45-degree field of view:
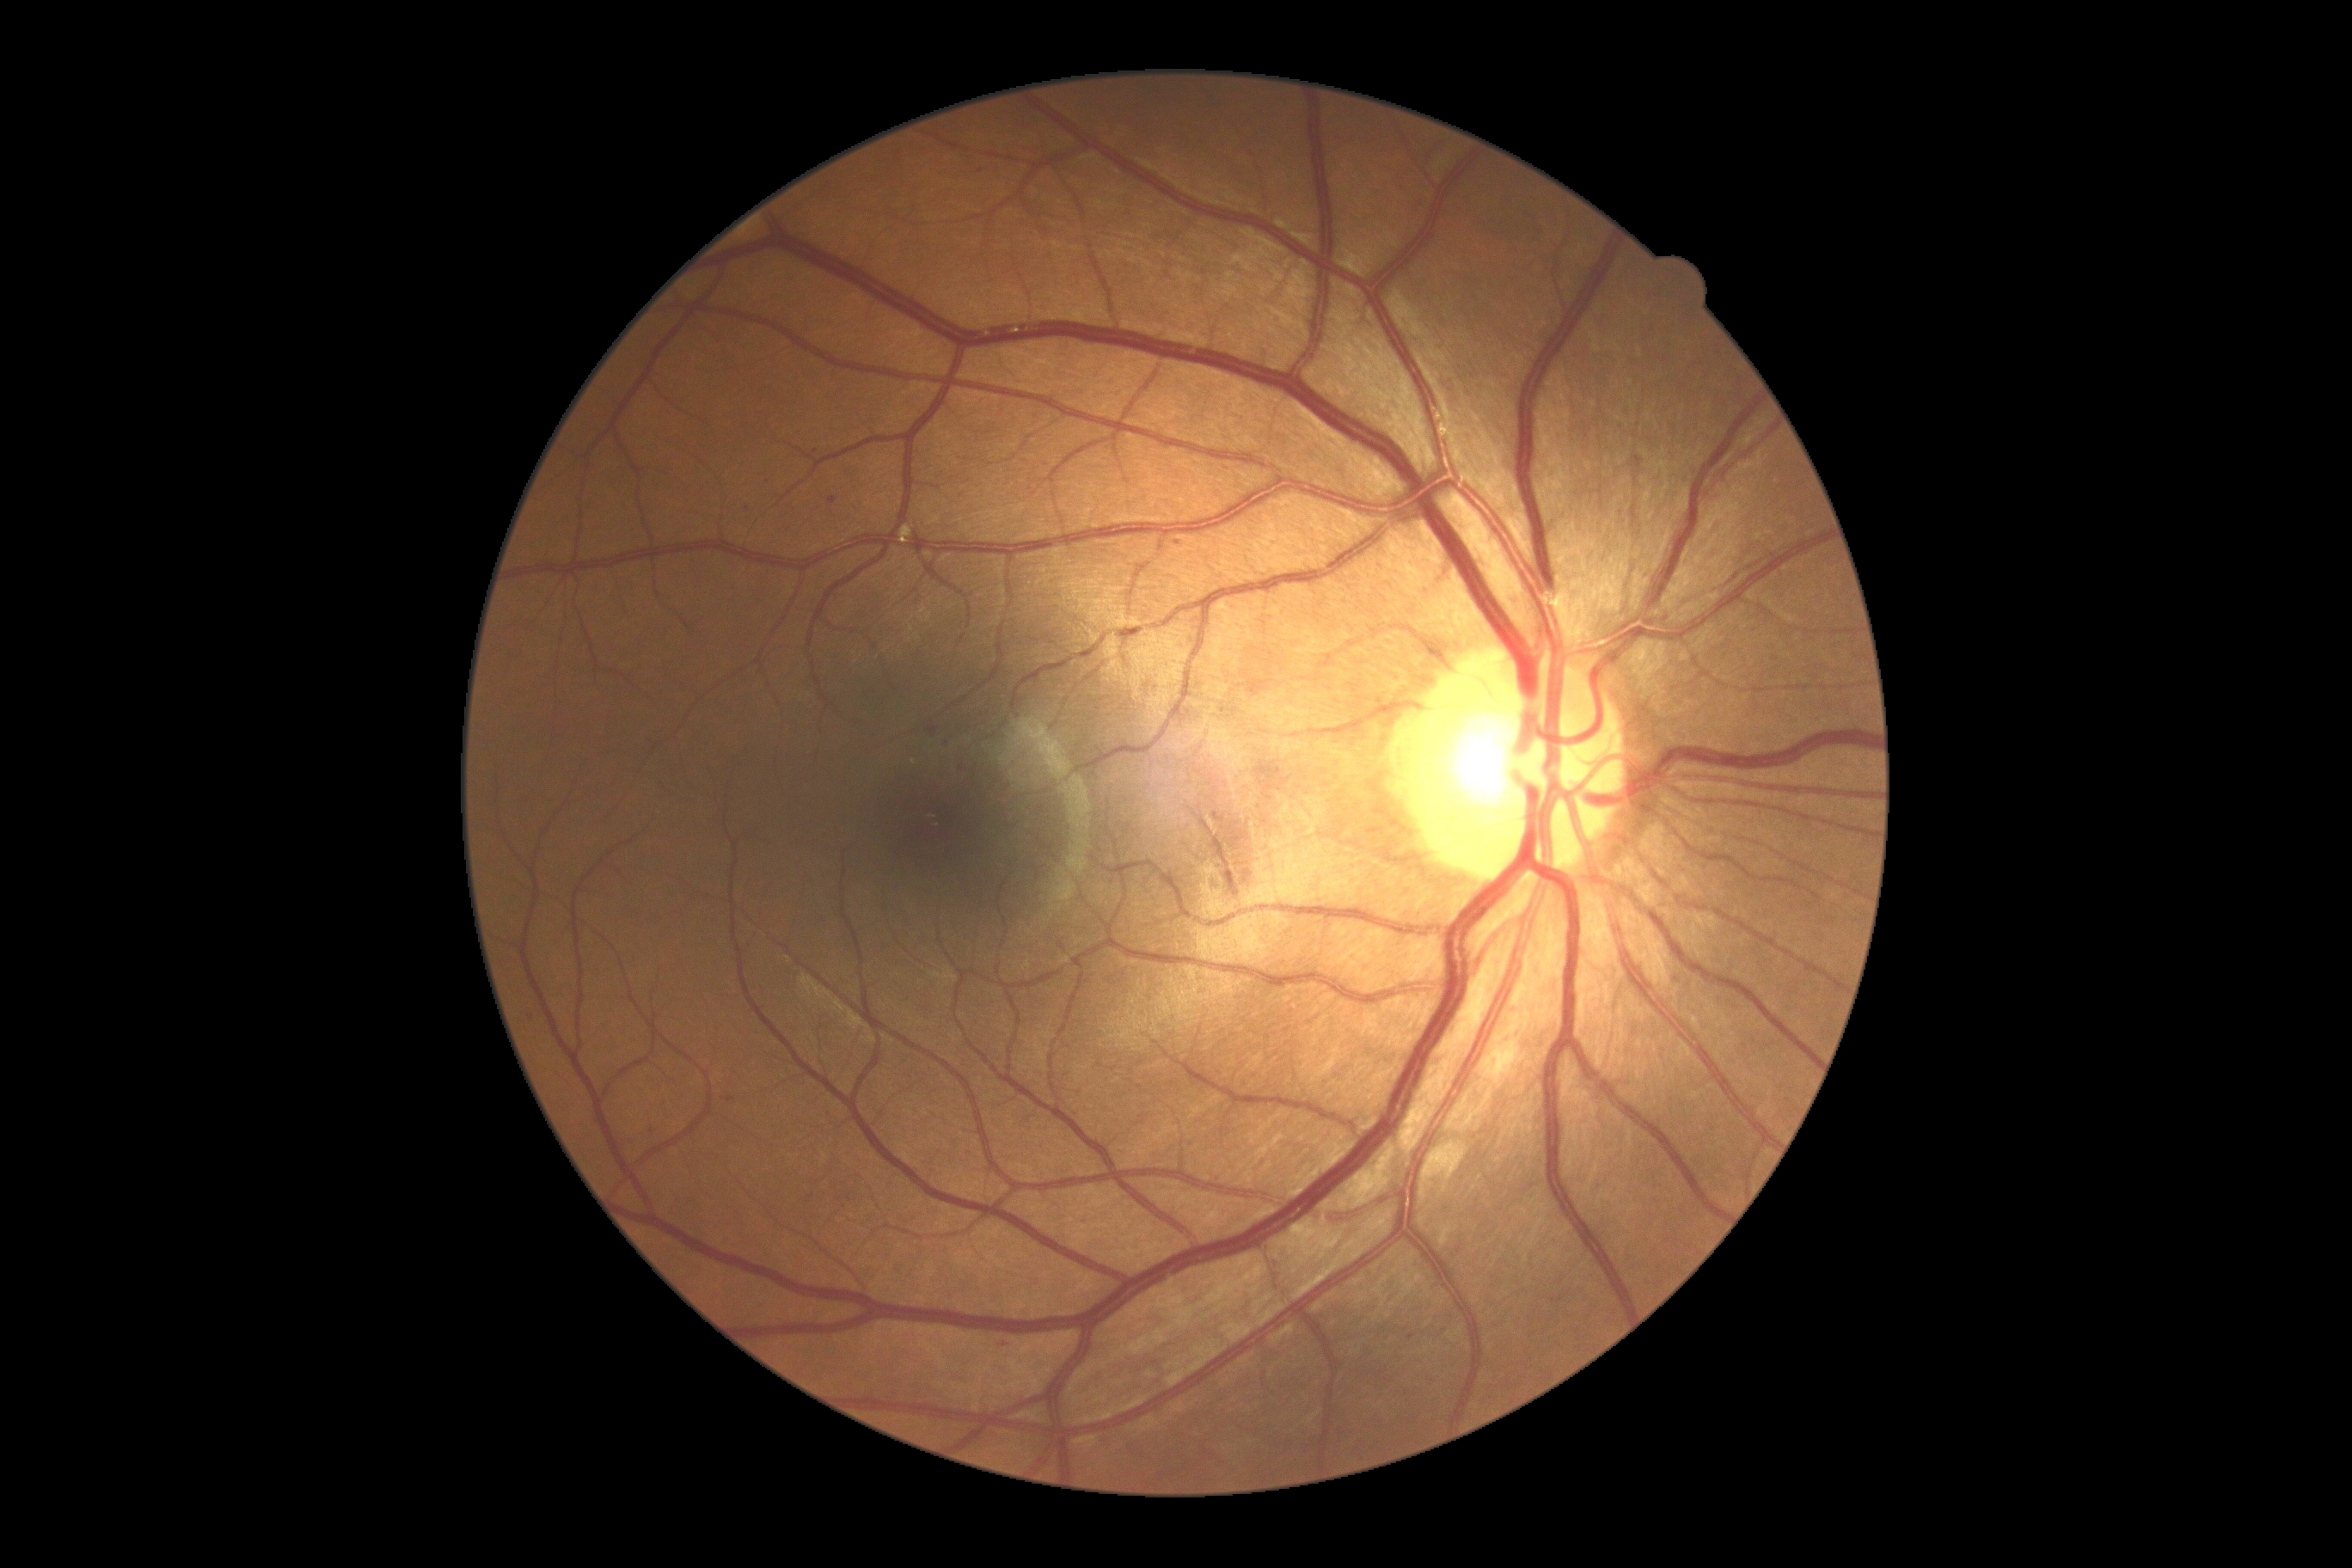

Diabetic retinopathy (DR) is moderate non-proliferative diabetic retinopathy (grade 2) — more than just microaneurysms but less than severe NPDR.